No pharmacologic dilation.
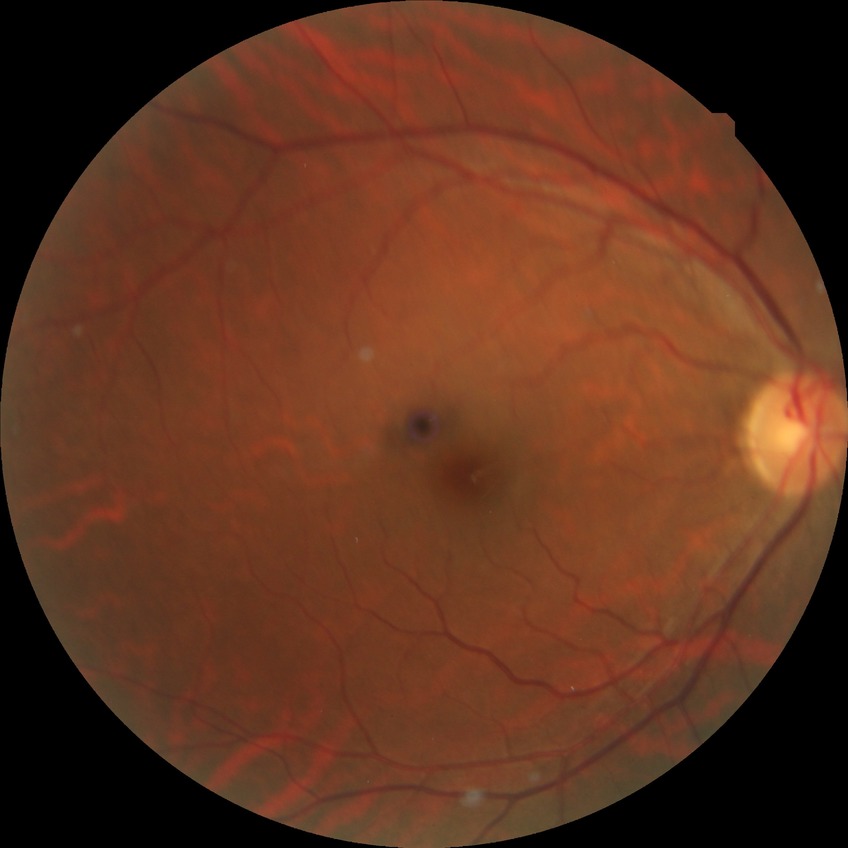

Diabetic retinopathy stage is no diabetic retinopathy.